FOV: 45 degrees, 2212x1672
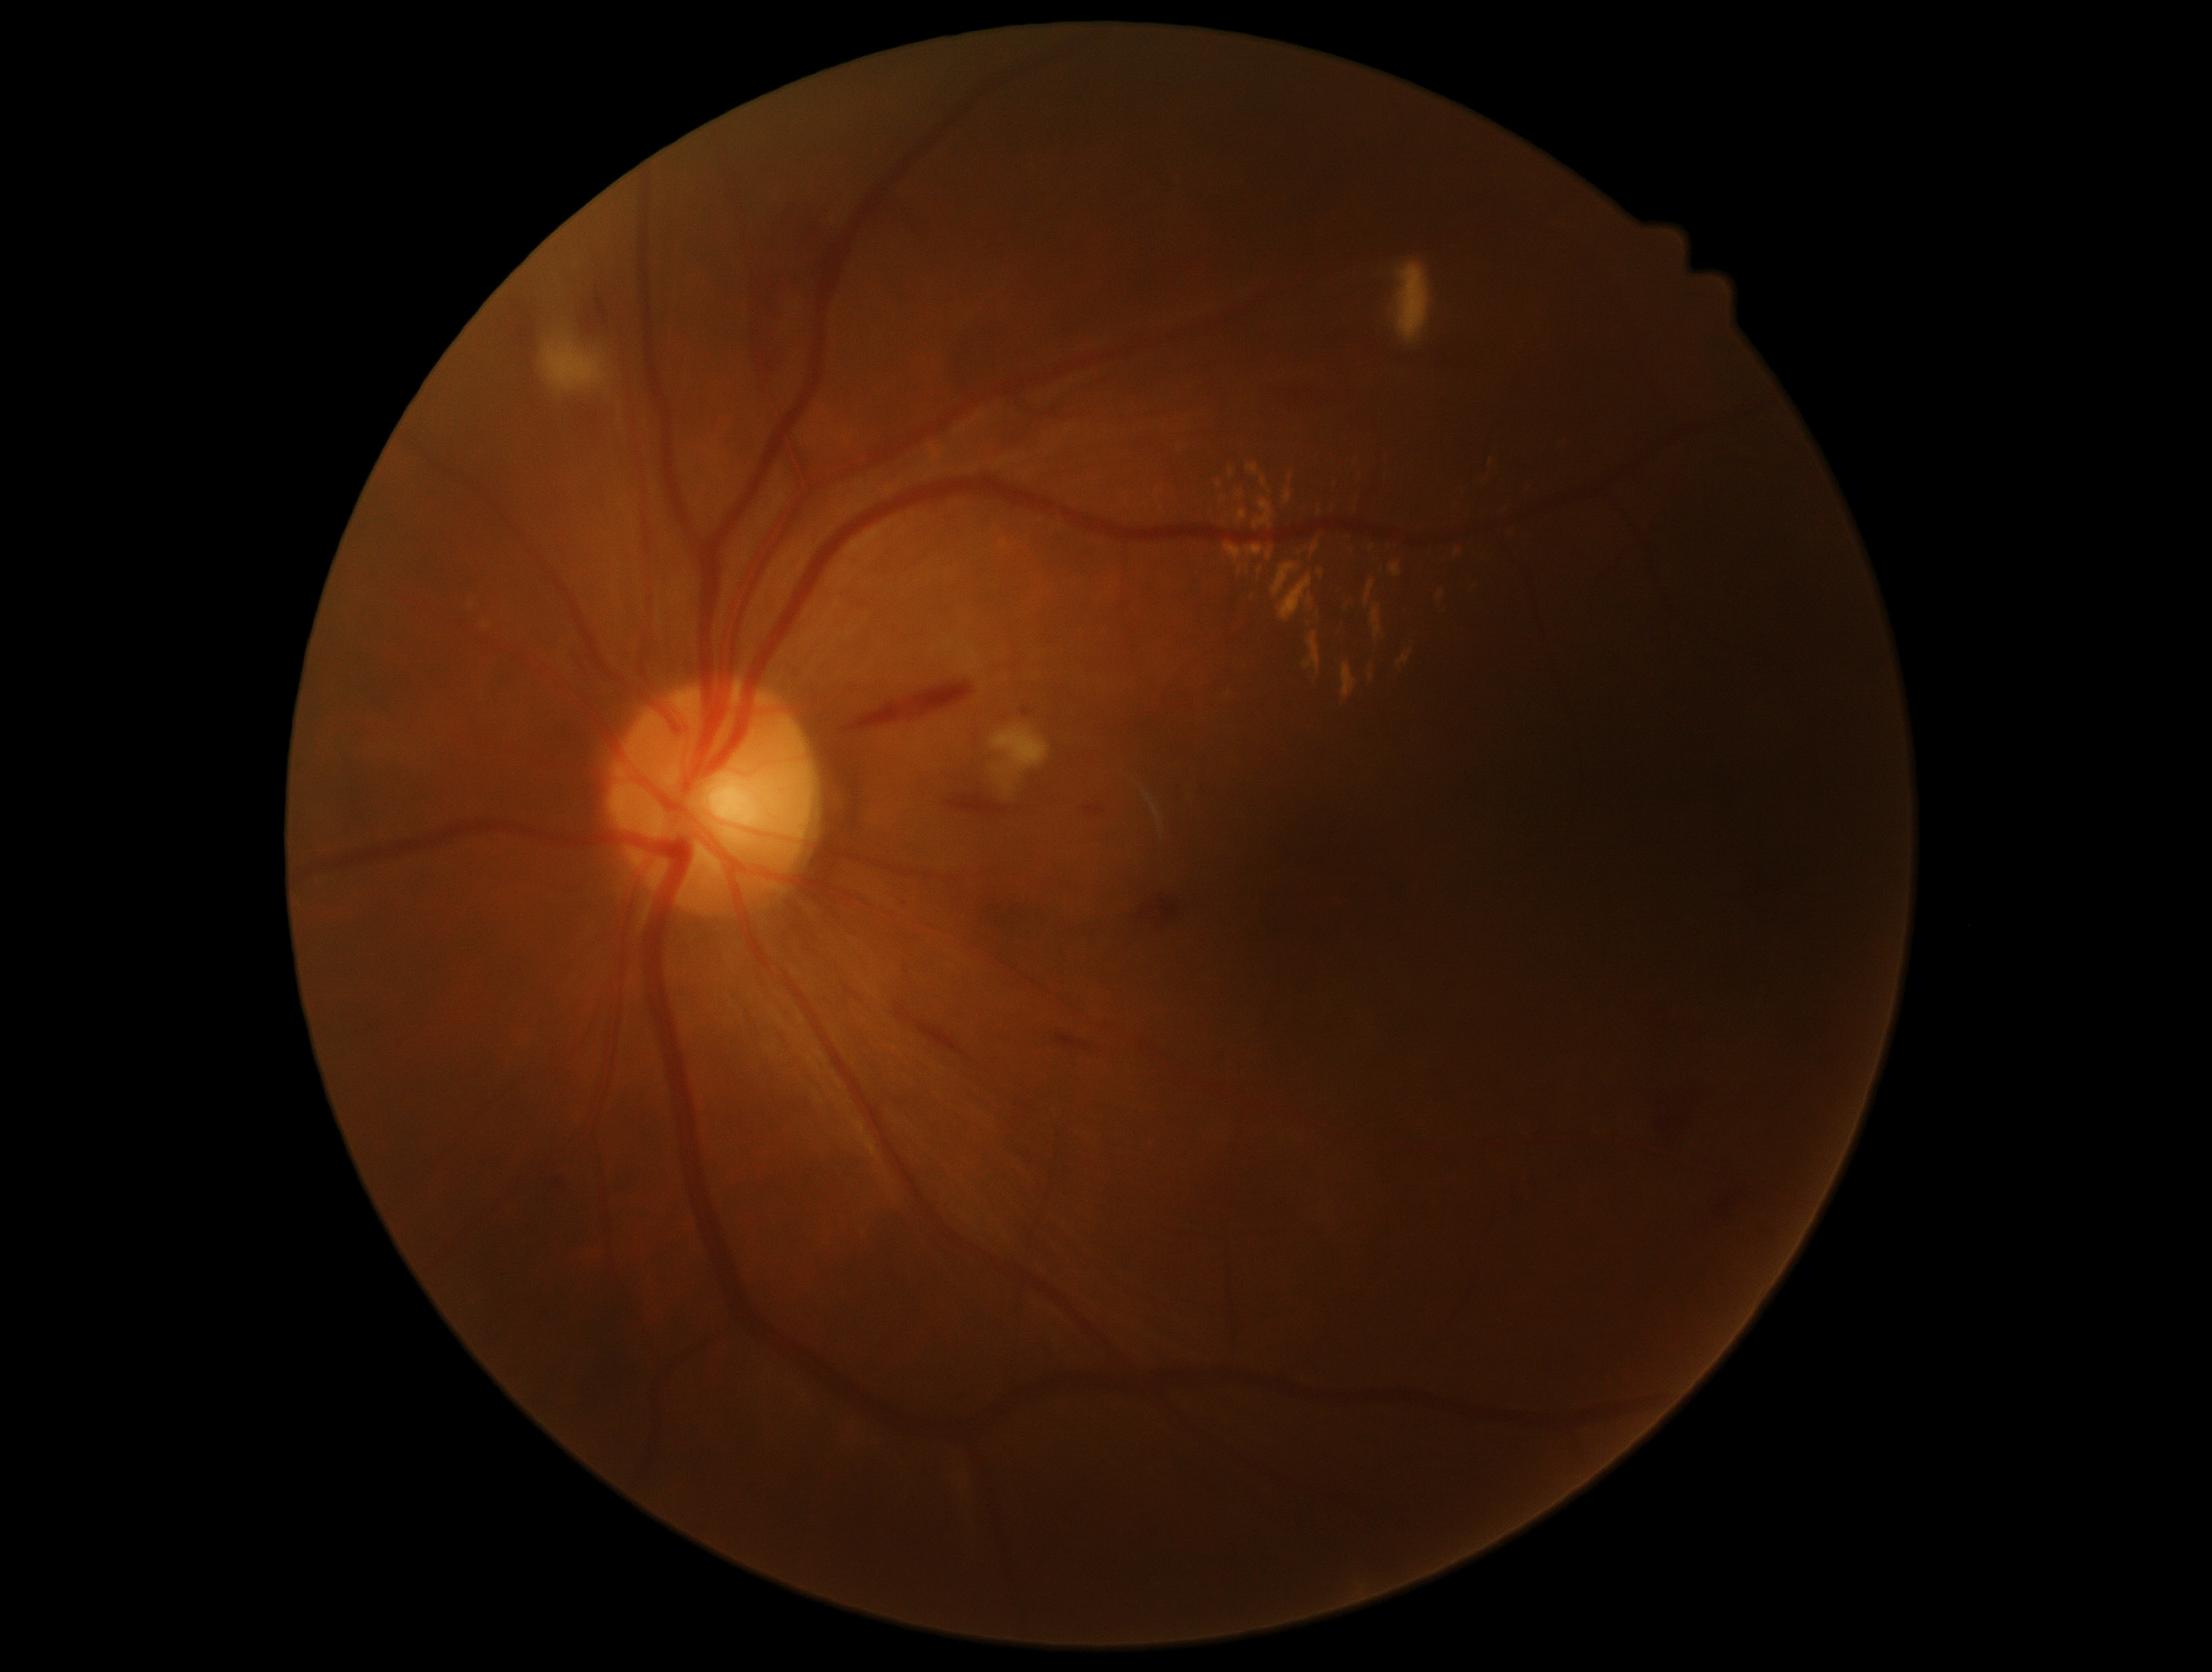
DR grade is moderate non-proliferative diabetic retinopathy (2).